Portable fundus camera image:
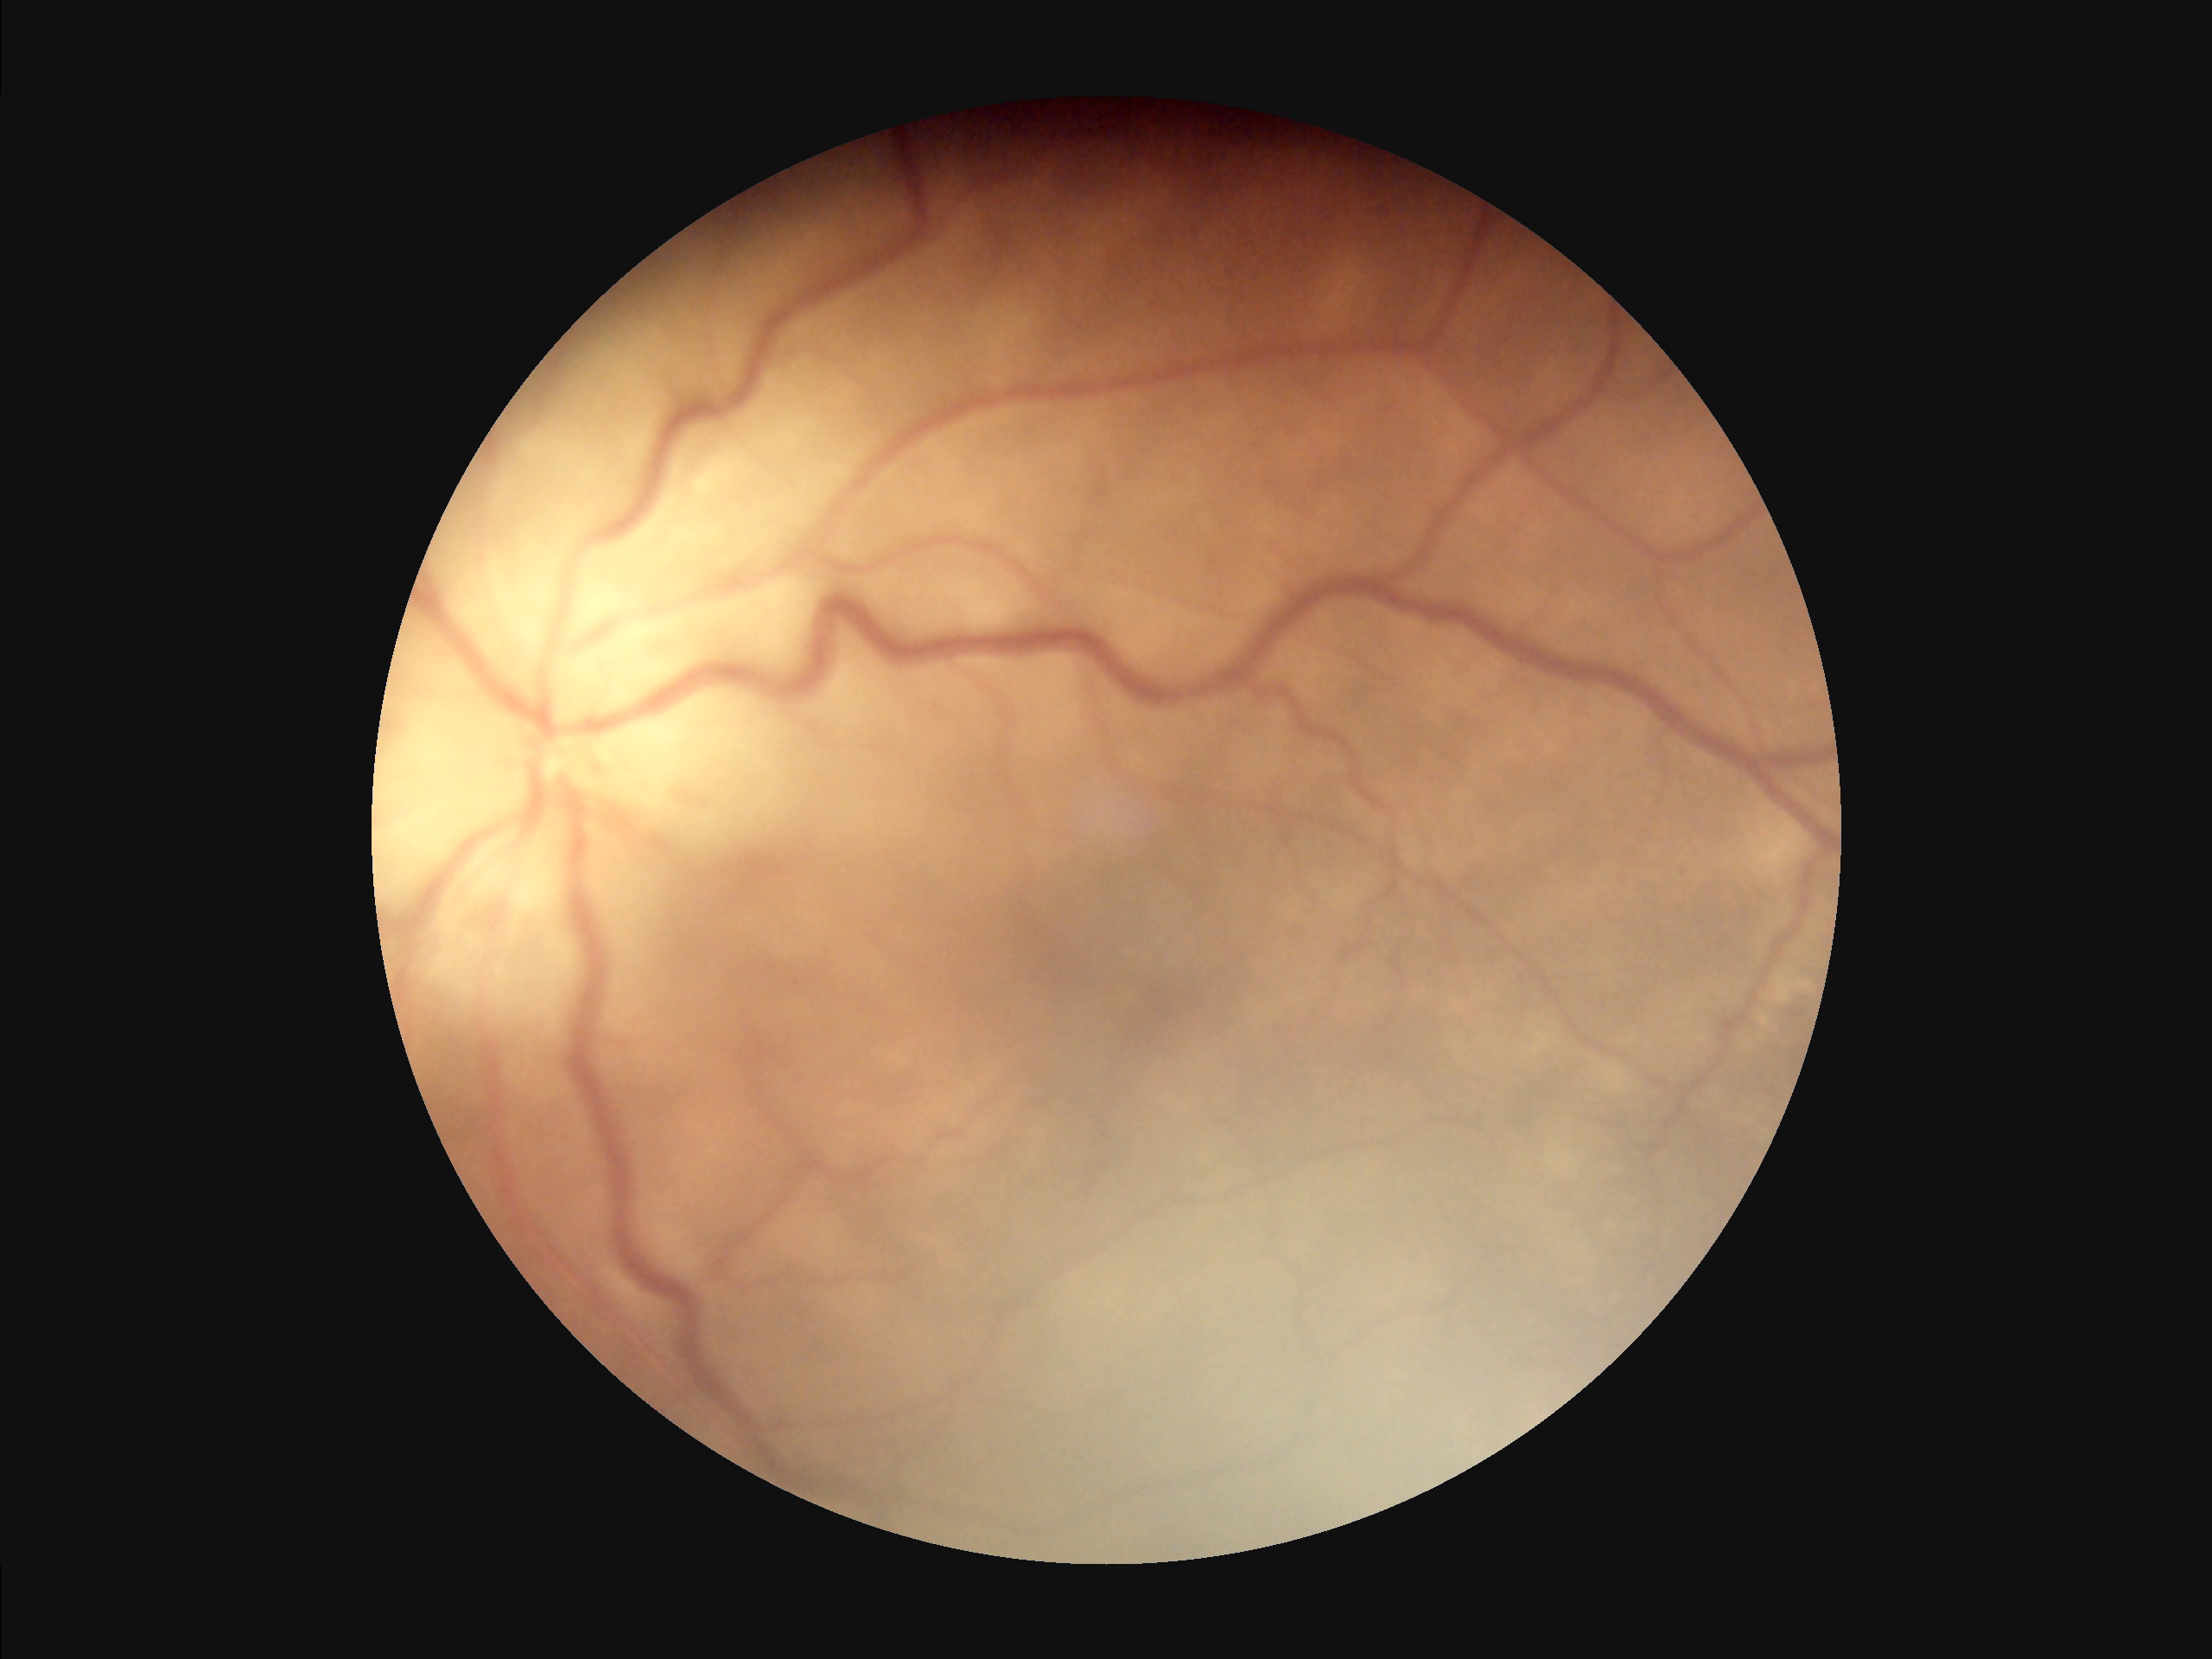
Image quality assessment: illumination/color: even and well-balanced | overall: poor and difficult to use diagnostically | contrast: good dynamic range | focus: reduced sharpness with visible blur.